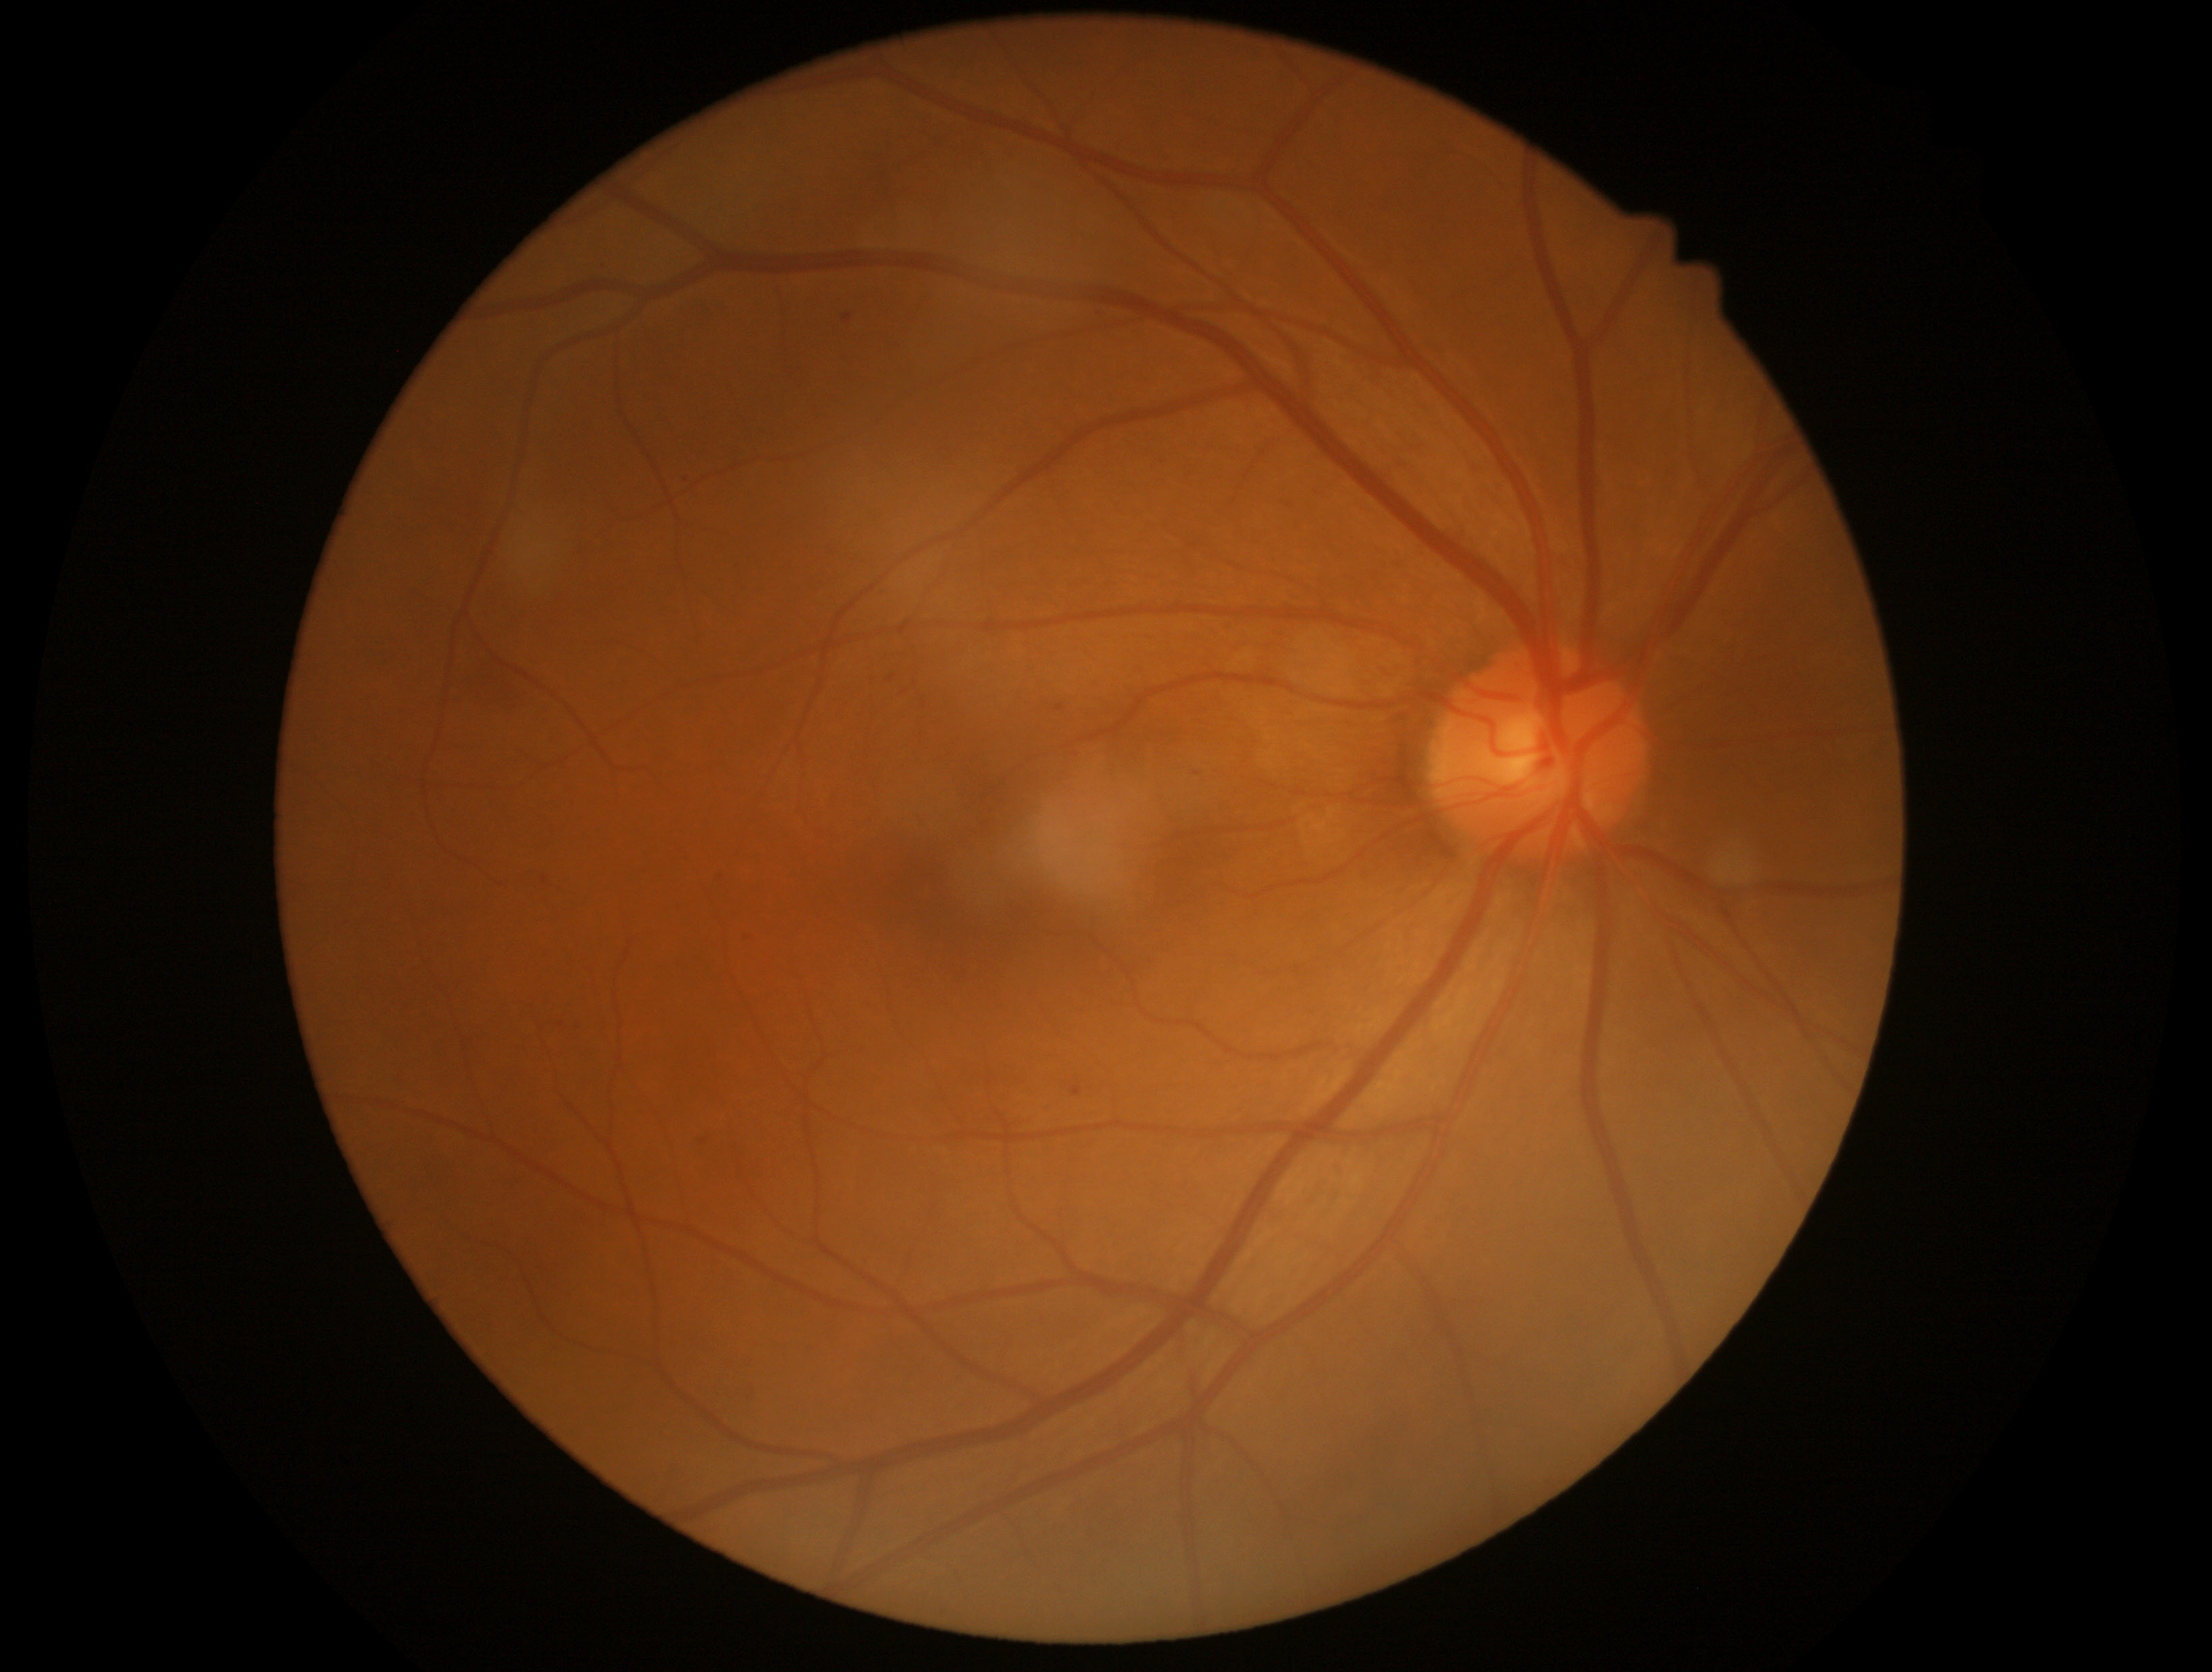 The retinopathy is classified as non-proliferative diabetic retinopathy. DR stage is 1.